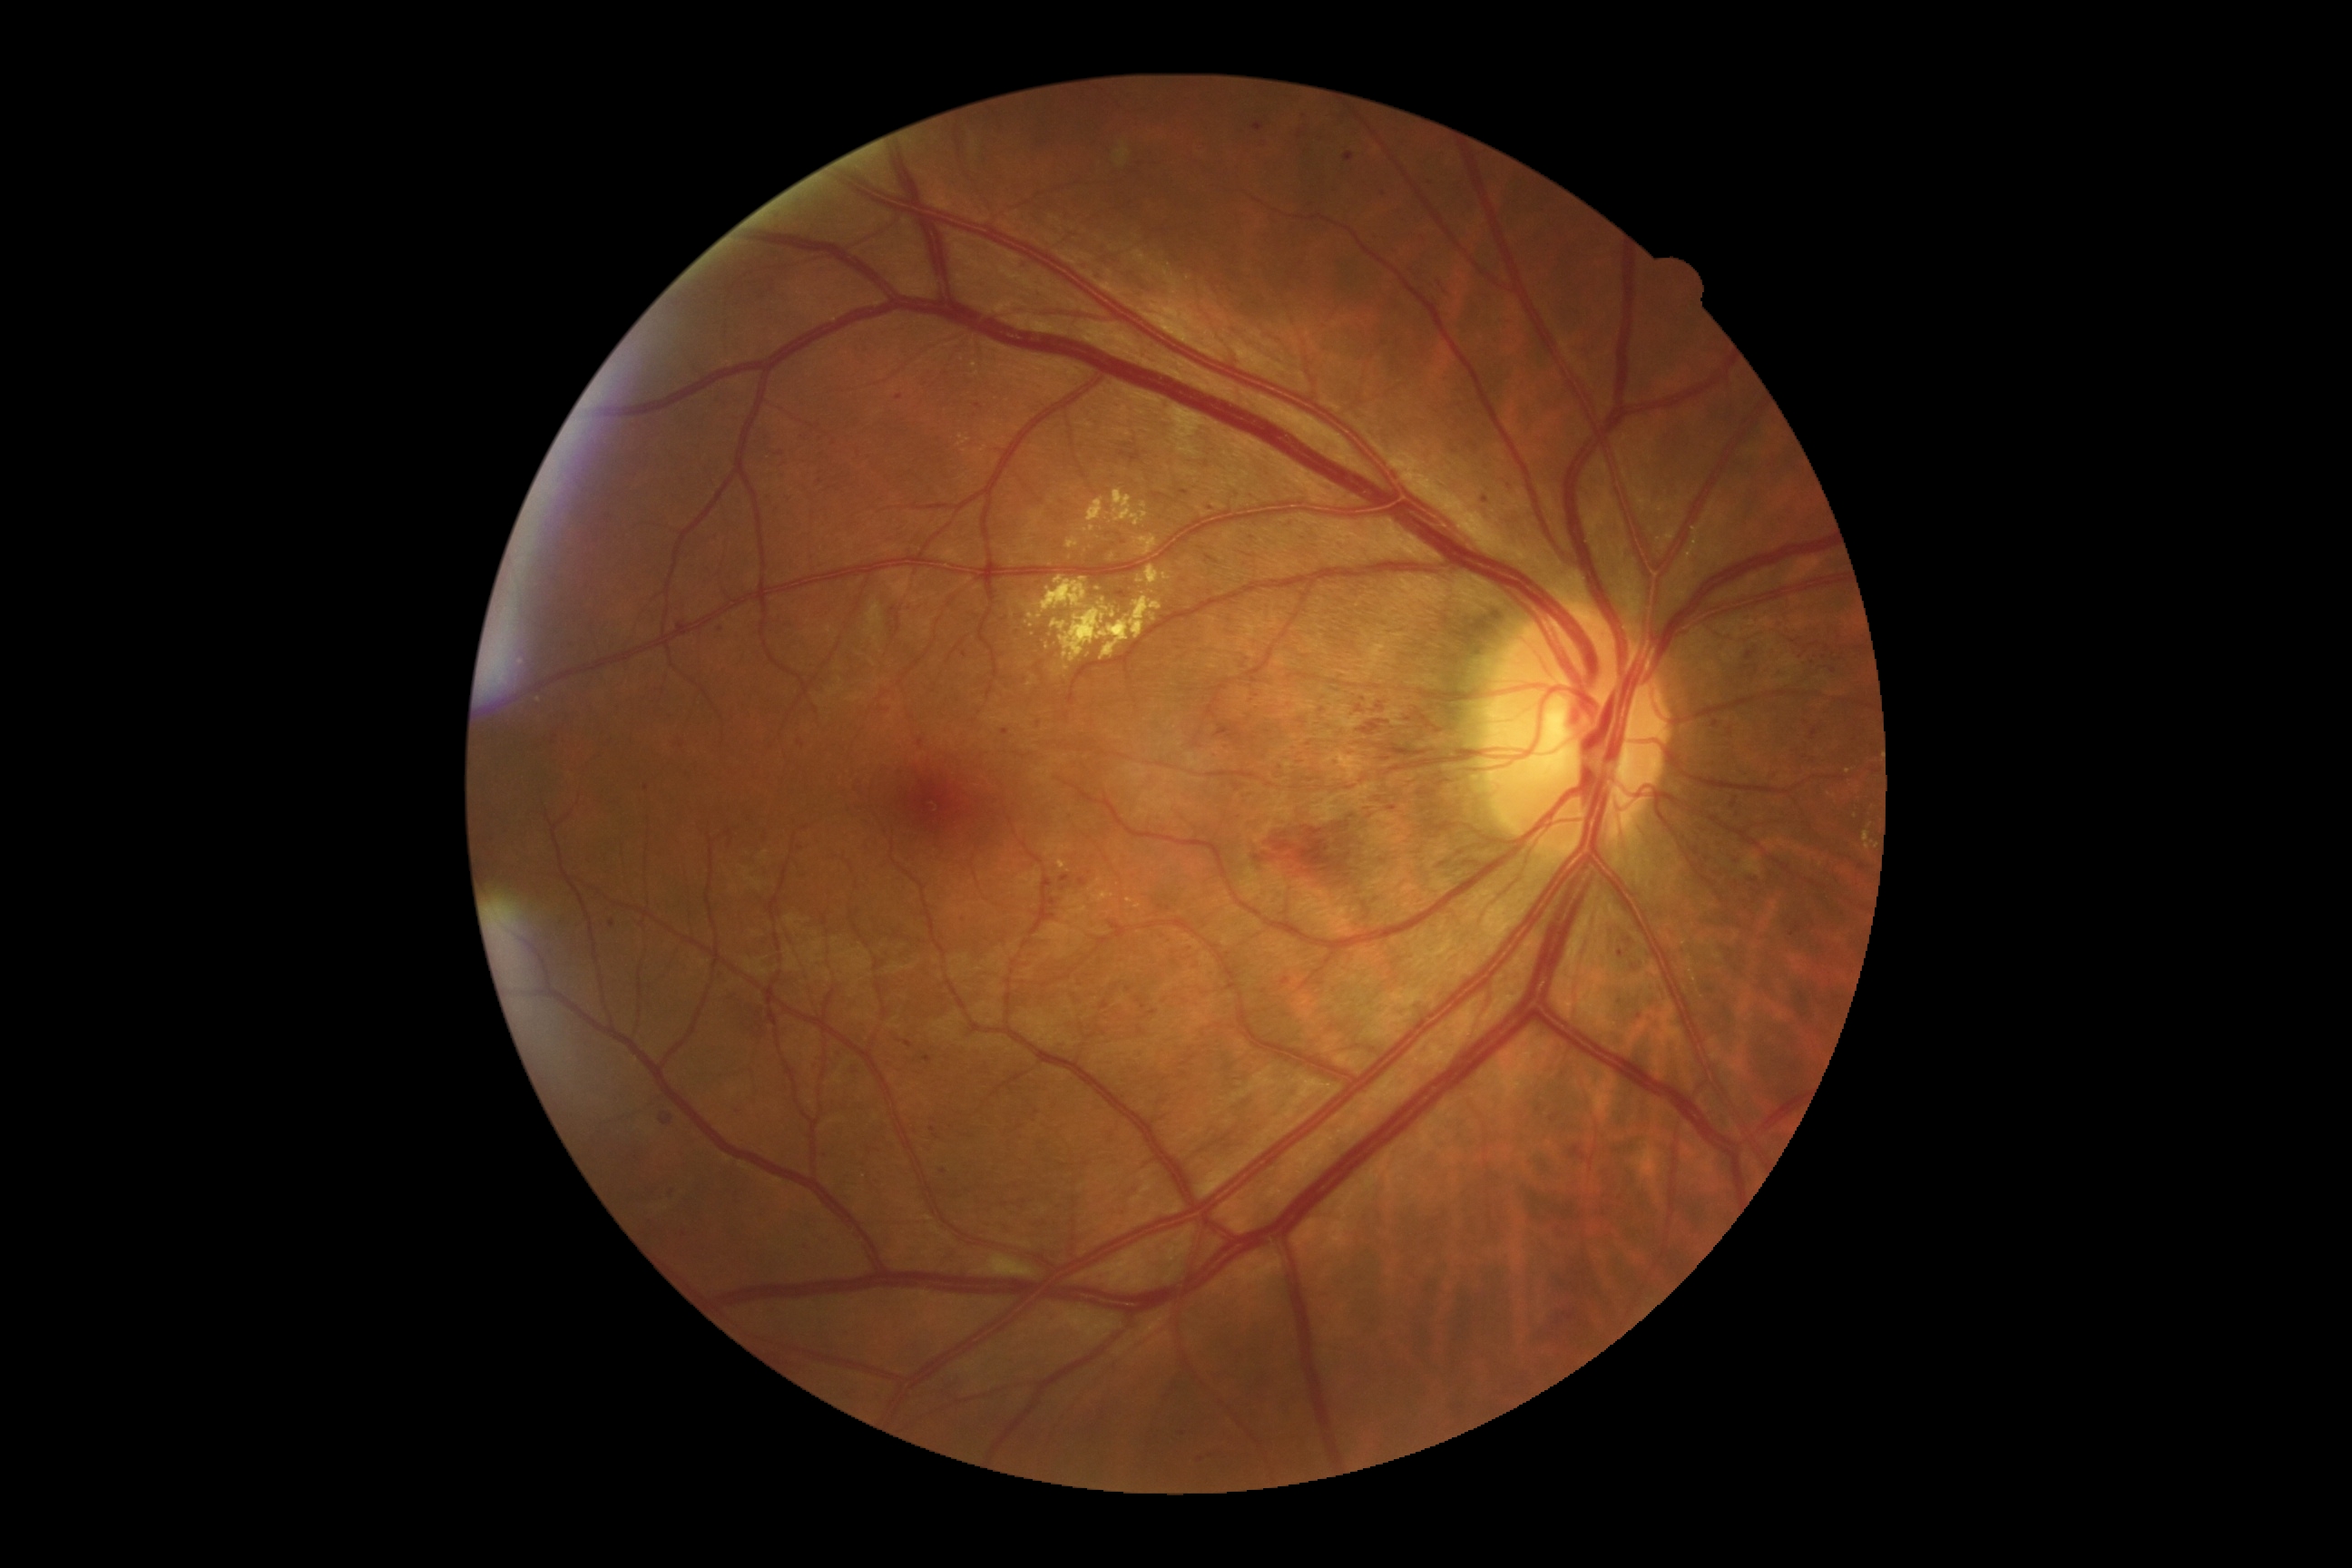 {"partial": true, "dr_grade": 3, "lesions": {"he": [[959, 651, 970, 662], [660, 1113, 672, 1126], [923, 1055, 934, 1063], [1317, 133, 1324, 142], [1101, 1121, 1119, 1144], [1081, 262, 1088, 270], [1050, 1099, 1059, 1110], [1418, 235, 1427, 246], [1556, 1317, 1562, 1326], [1563, 1311, 1576, 1322], [723, 992, 769, 1039], [876, 703, 892, 716], [1001, 729, 1010, 736], [1024, 1217, 1050, 1228]], "he_small_approx": [[1041, 636], [647, 788], [781, 454], [1320, 983]], "ex": [[1162, 573, 1171, 582], [1135, 536, 1159, 556], [957, 435, 970, 447], [1681, 941, 1689, 946], [1863, 832, 1870, 850], [1112, 489, 1148, 527], [1112, 611, 1117, 620], [1687, 957, 1696, 983], [1059, 859, 1066, 870]], "ex_small_approx": [[973, 344], [1104, 600], [965, 451], [1144, 505]]}}